1936x1296px.
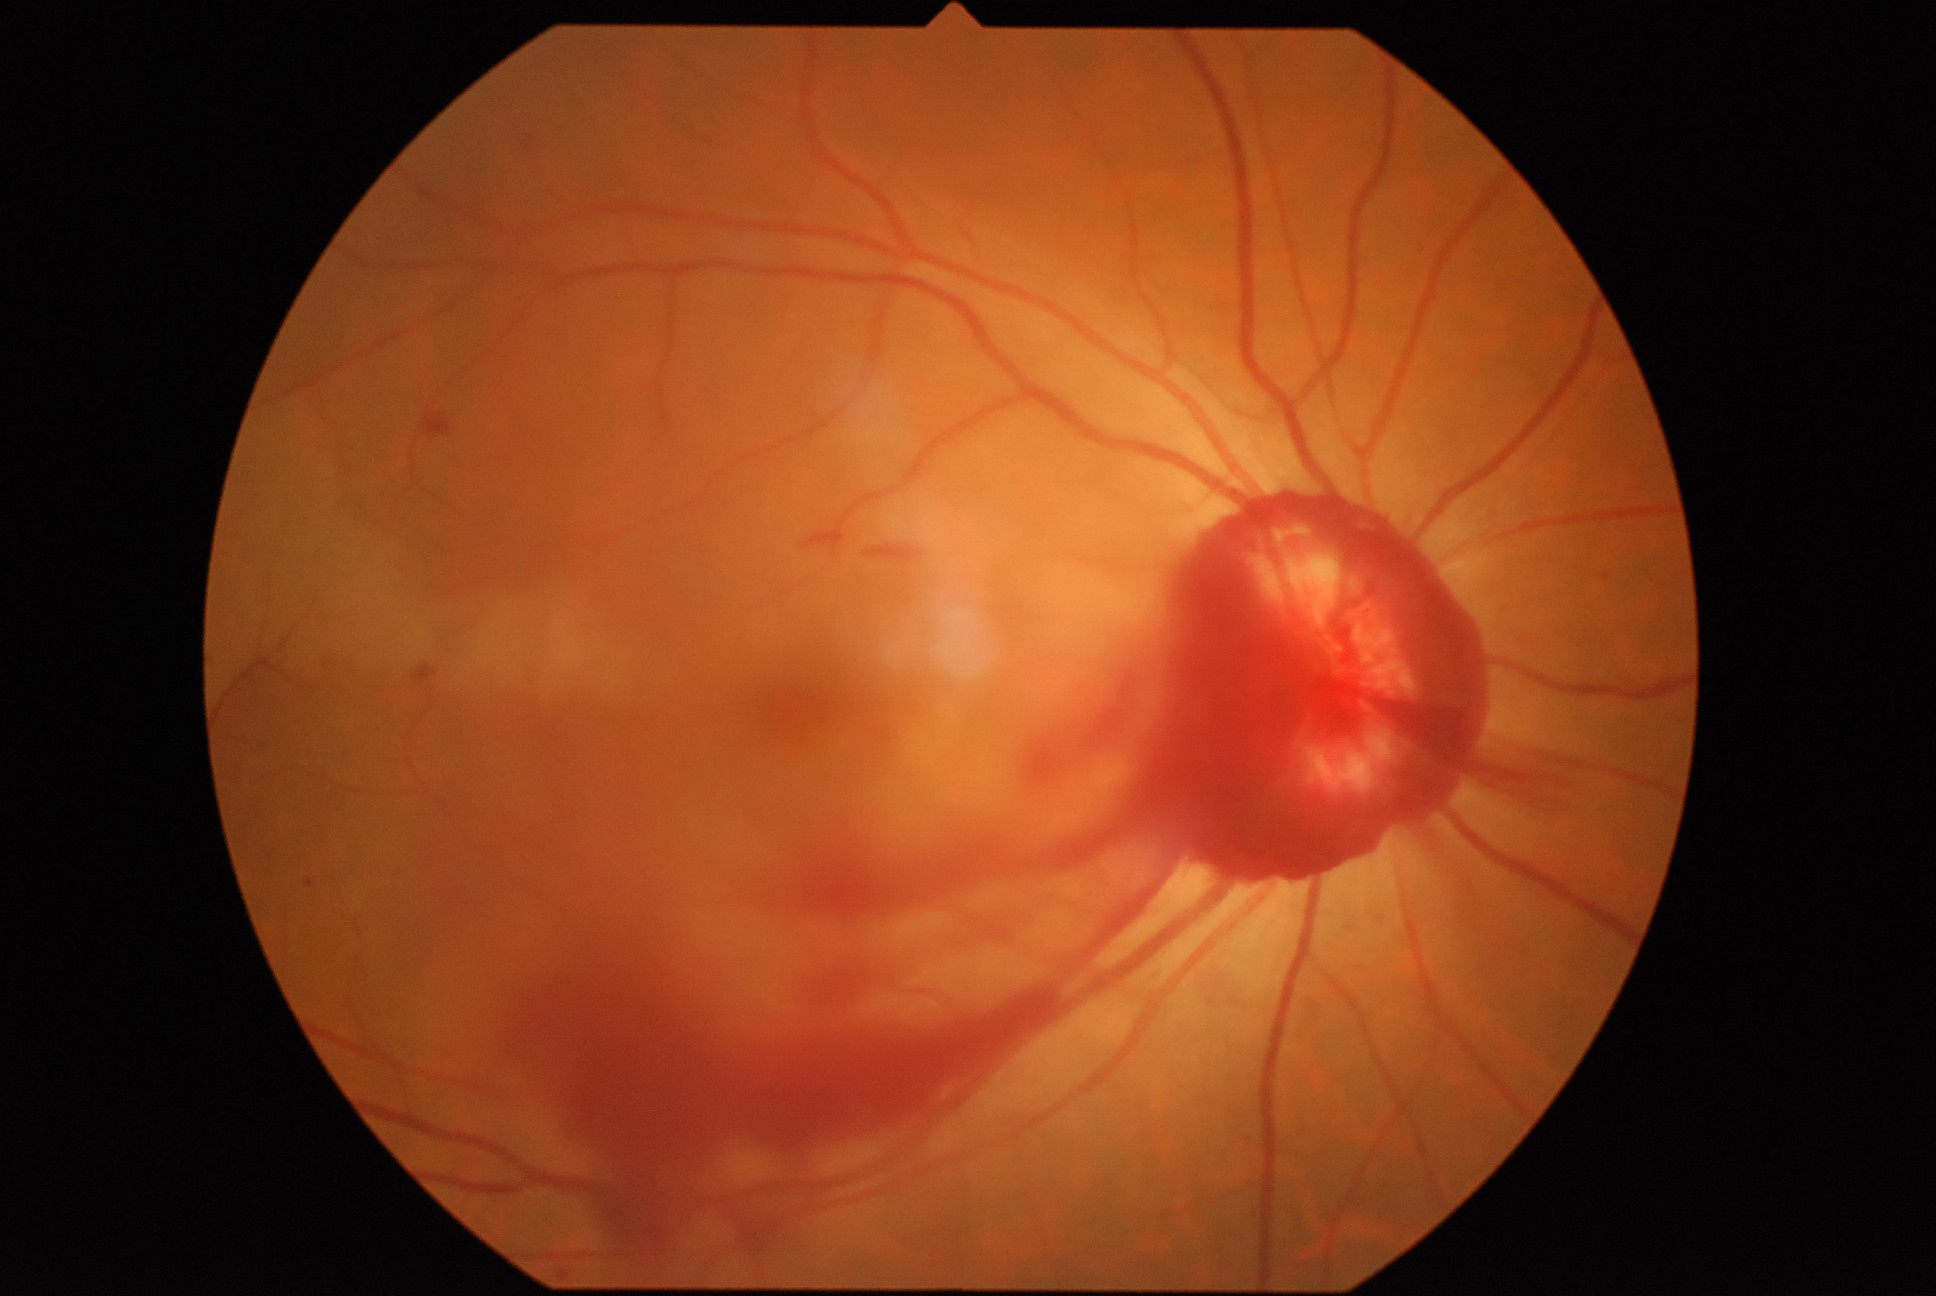   dr_grade: 4/4